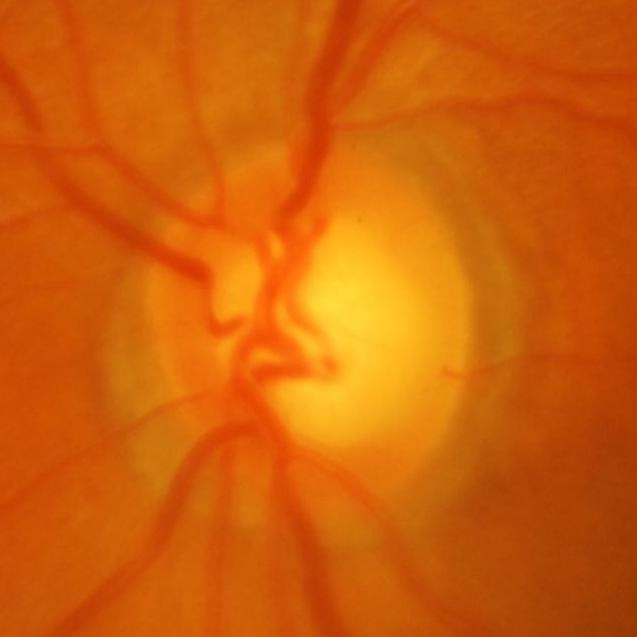

Findings consistent with glaucomatous optic neuropathy.